Fundus photo: 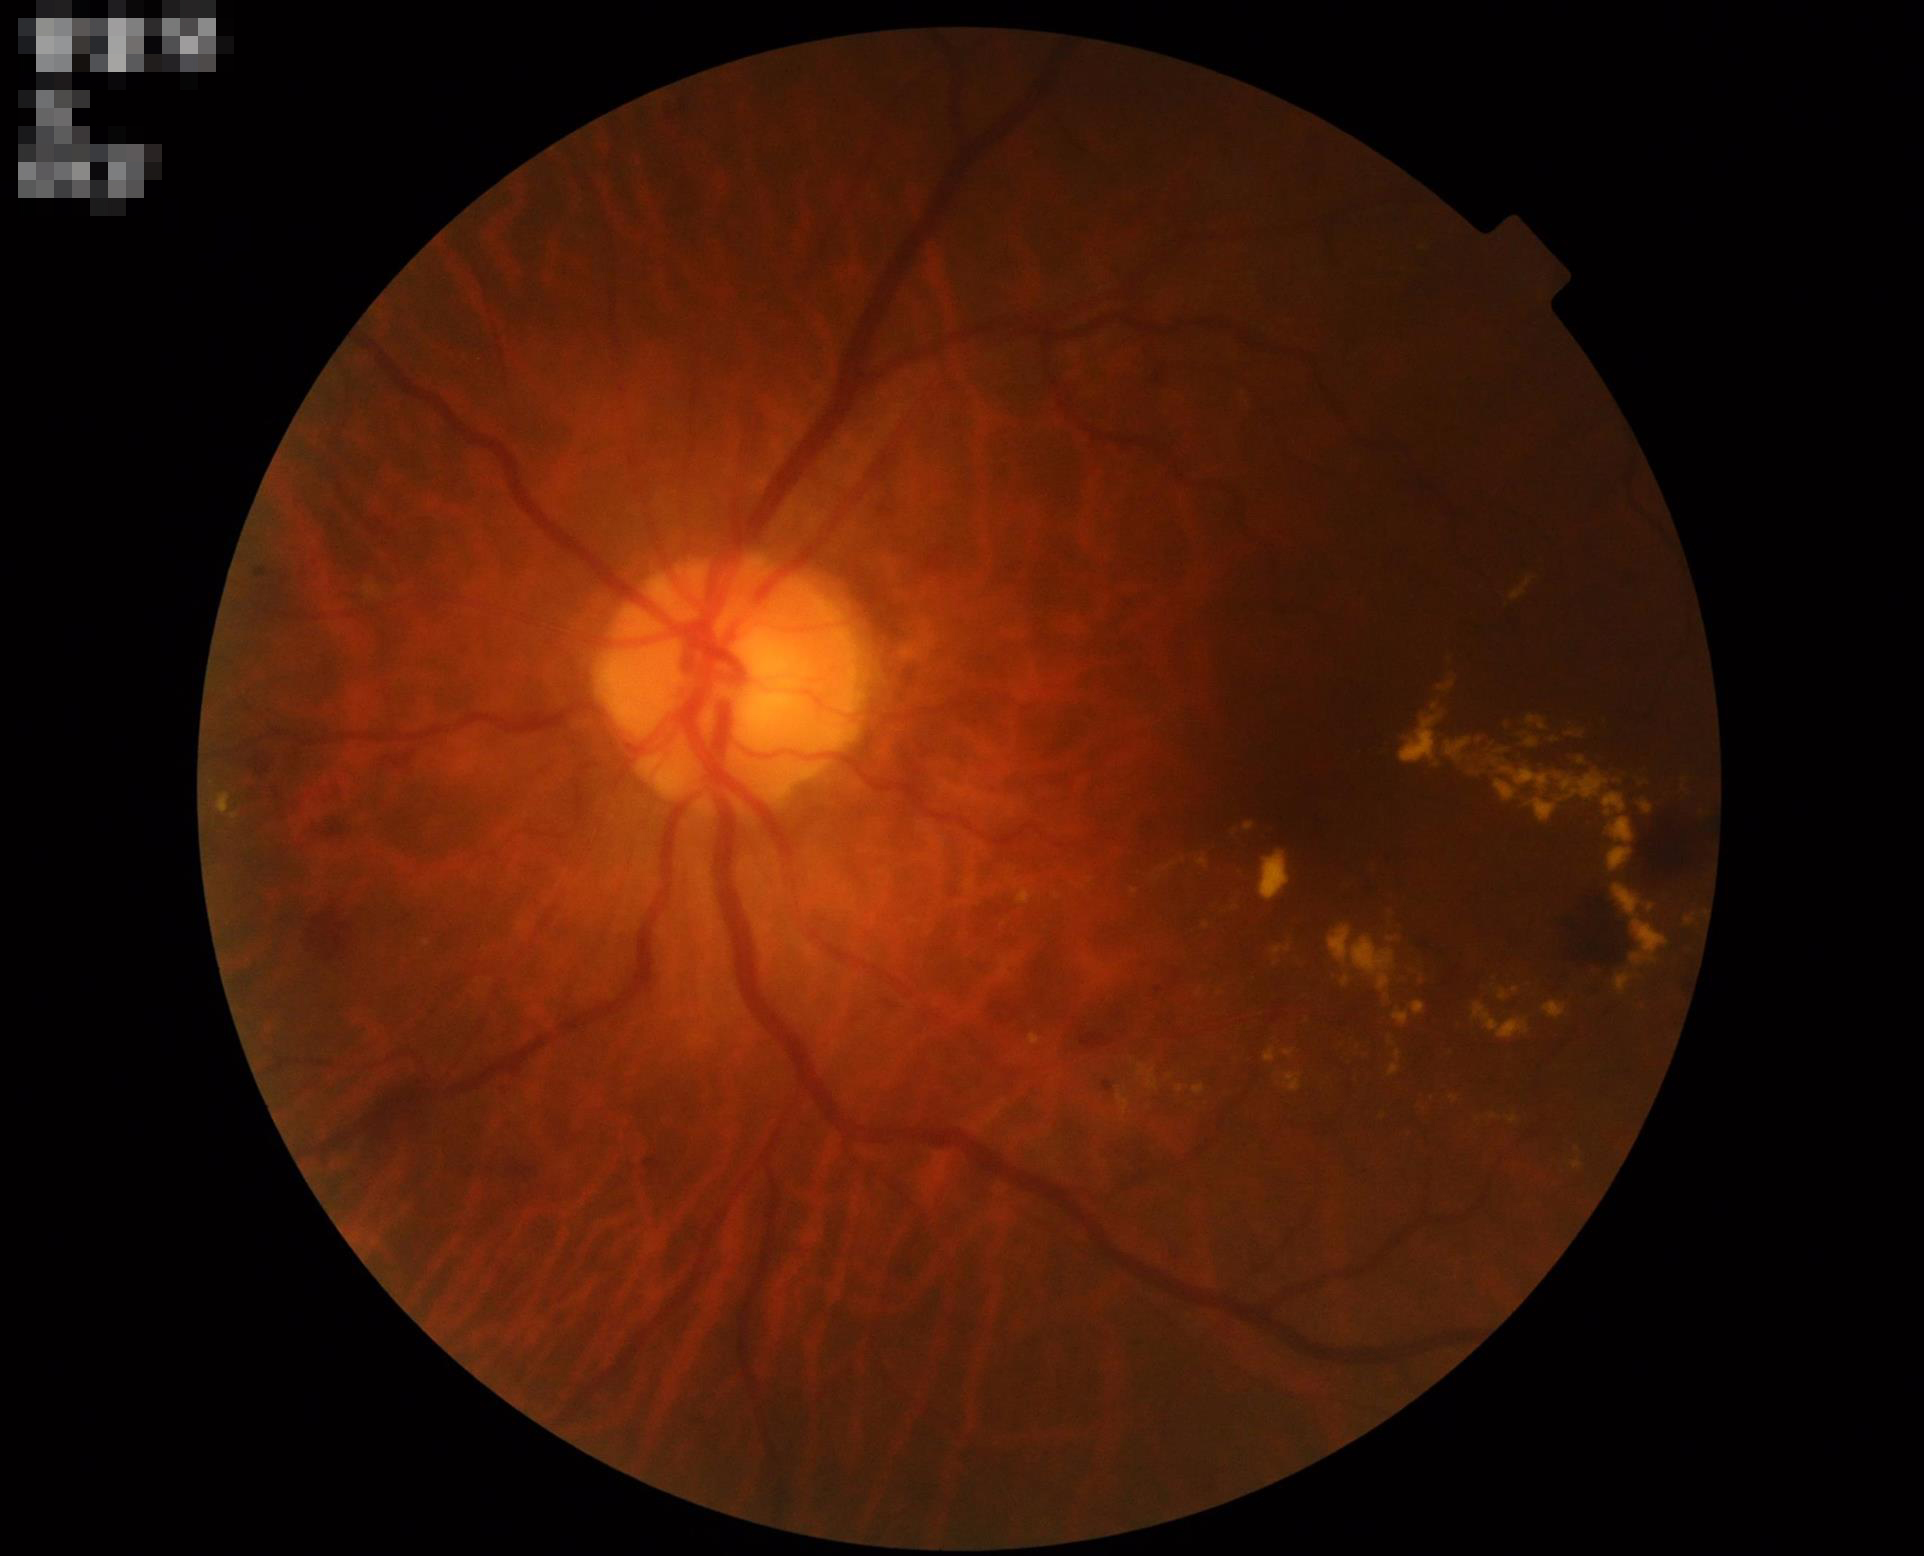

Illumination: over- or under-exposed | Overall: adequate for clinical interpretation | Contrast: vessels and details readily distinguishable.